45-degree field of view.
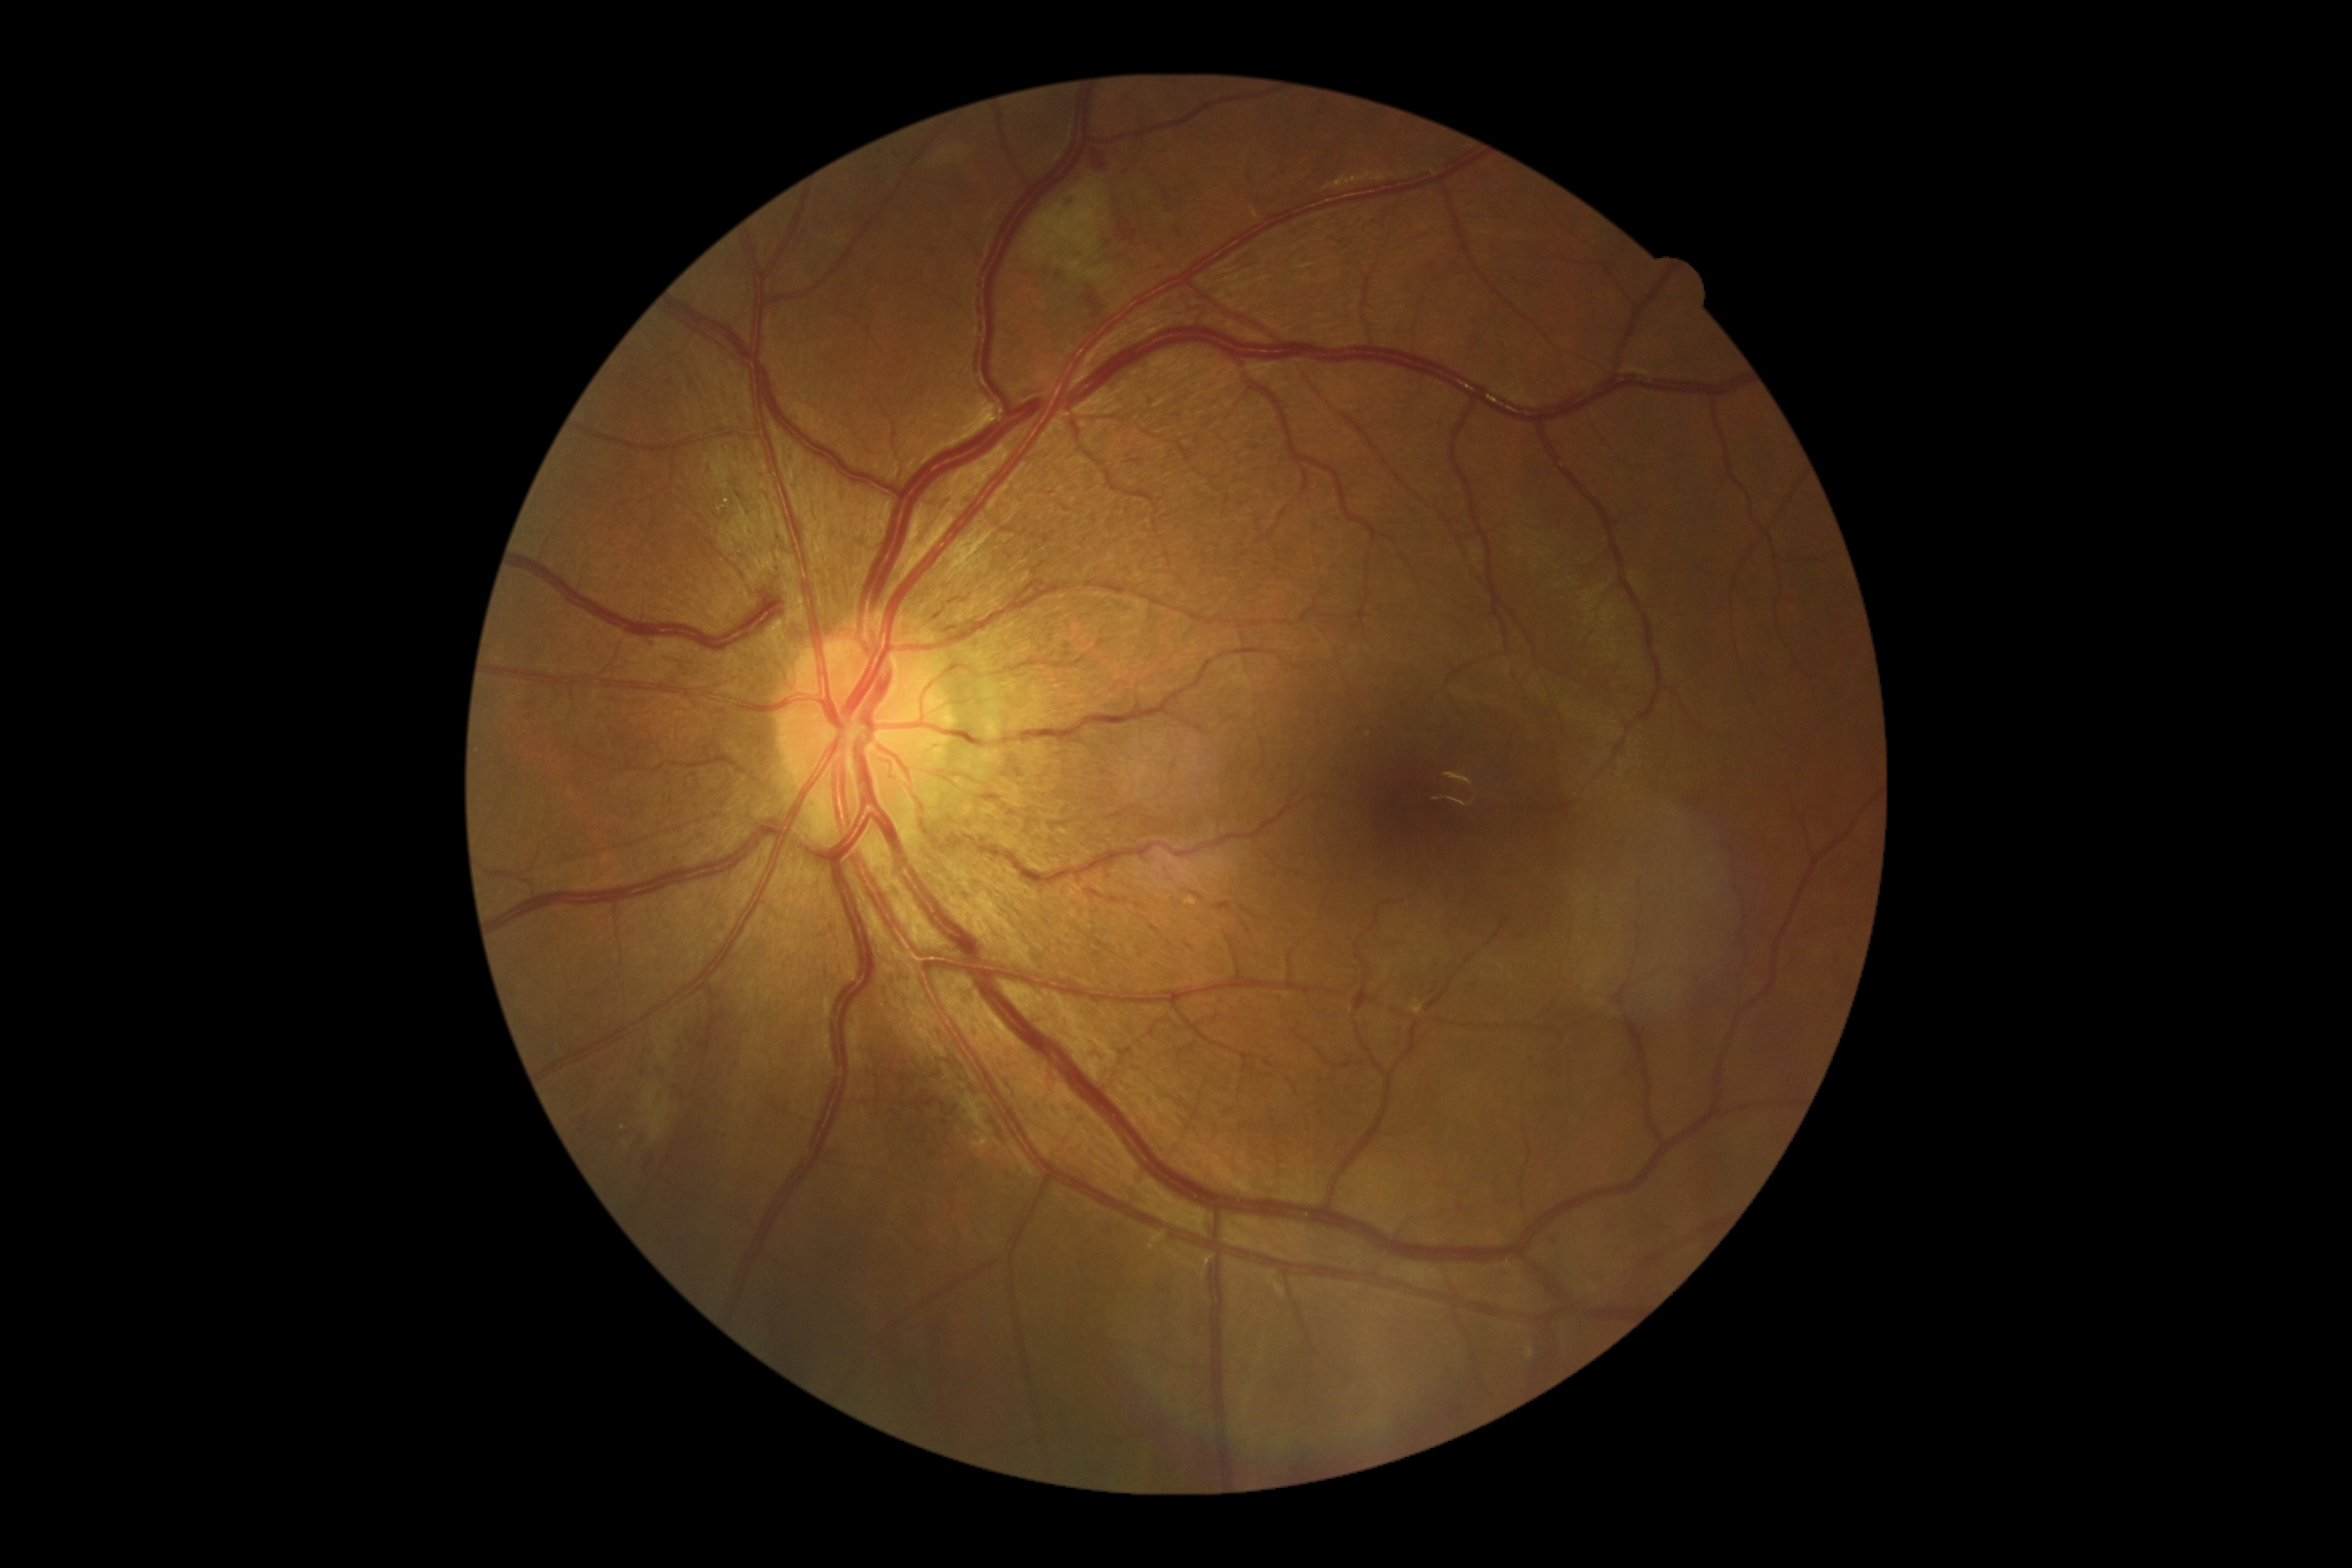
Diabetic retinopathy (DR) is grade 2 (moderate NPDR). Disease class: non-proliferative diabetic retinopathy.